Image size 2352x1568. 45° FOV. CFP:
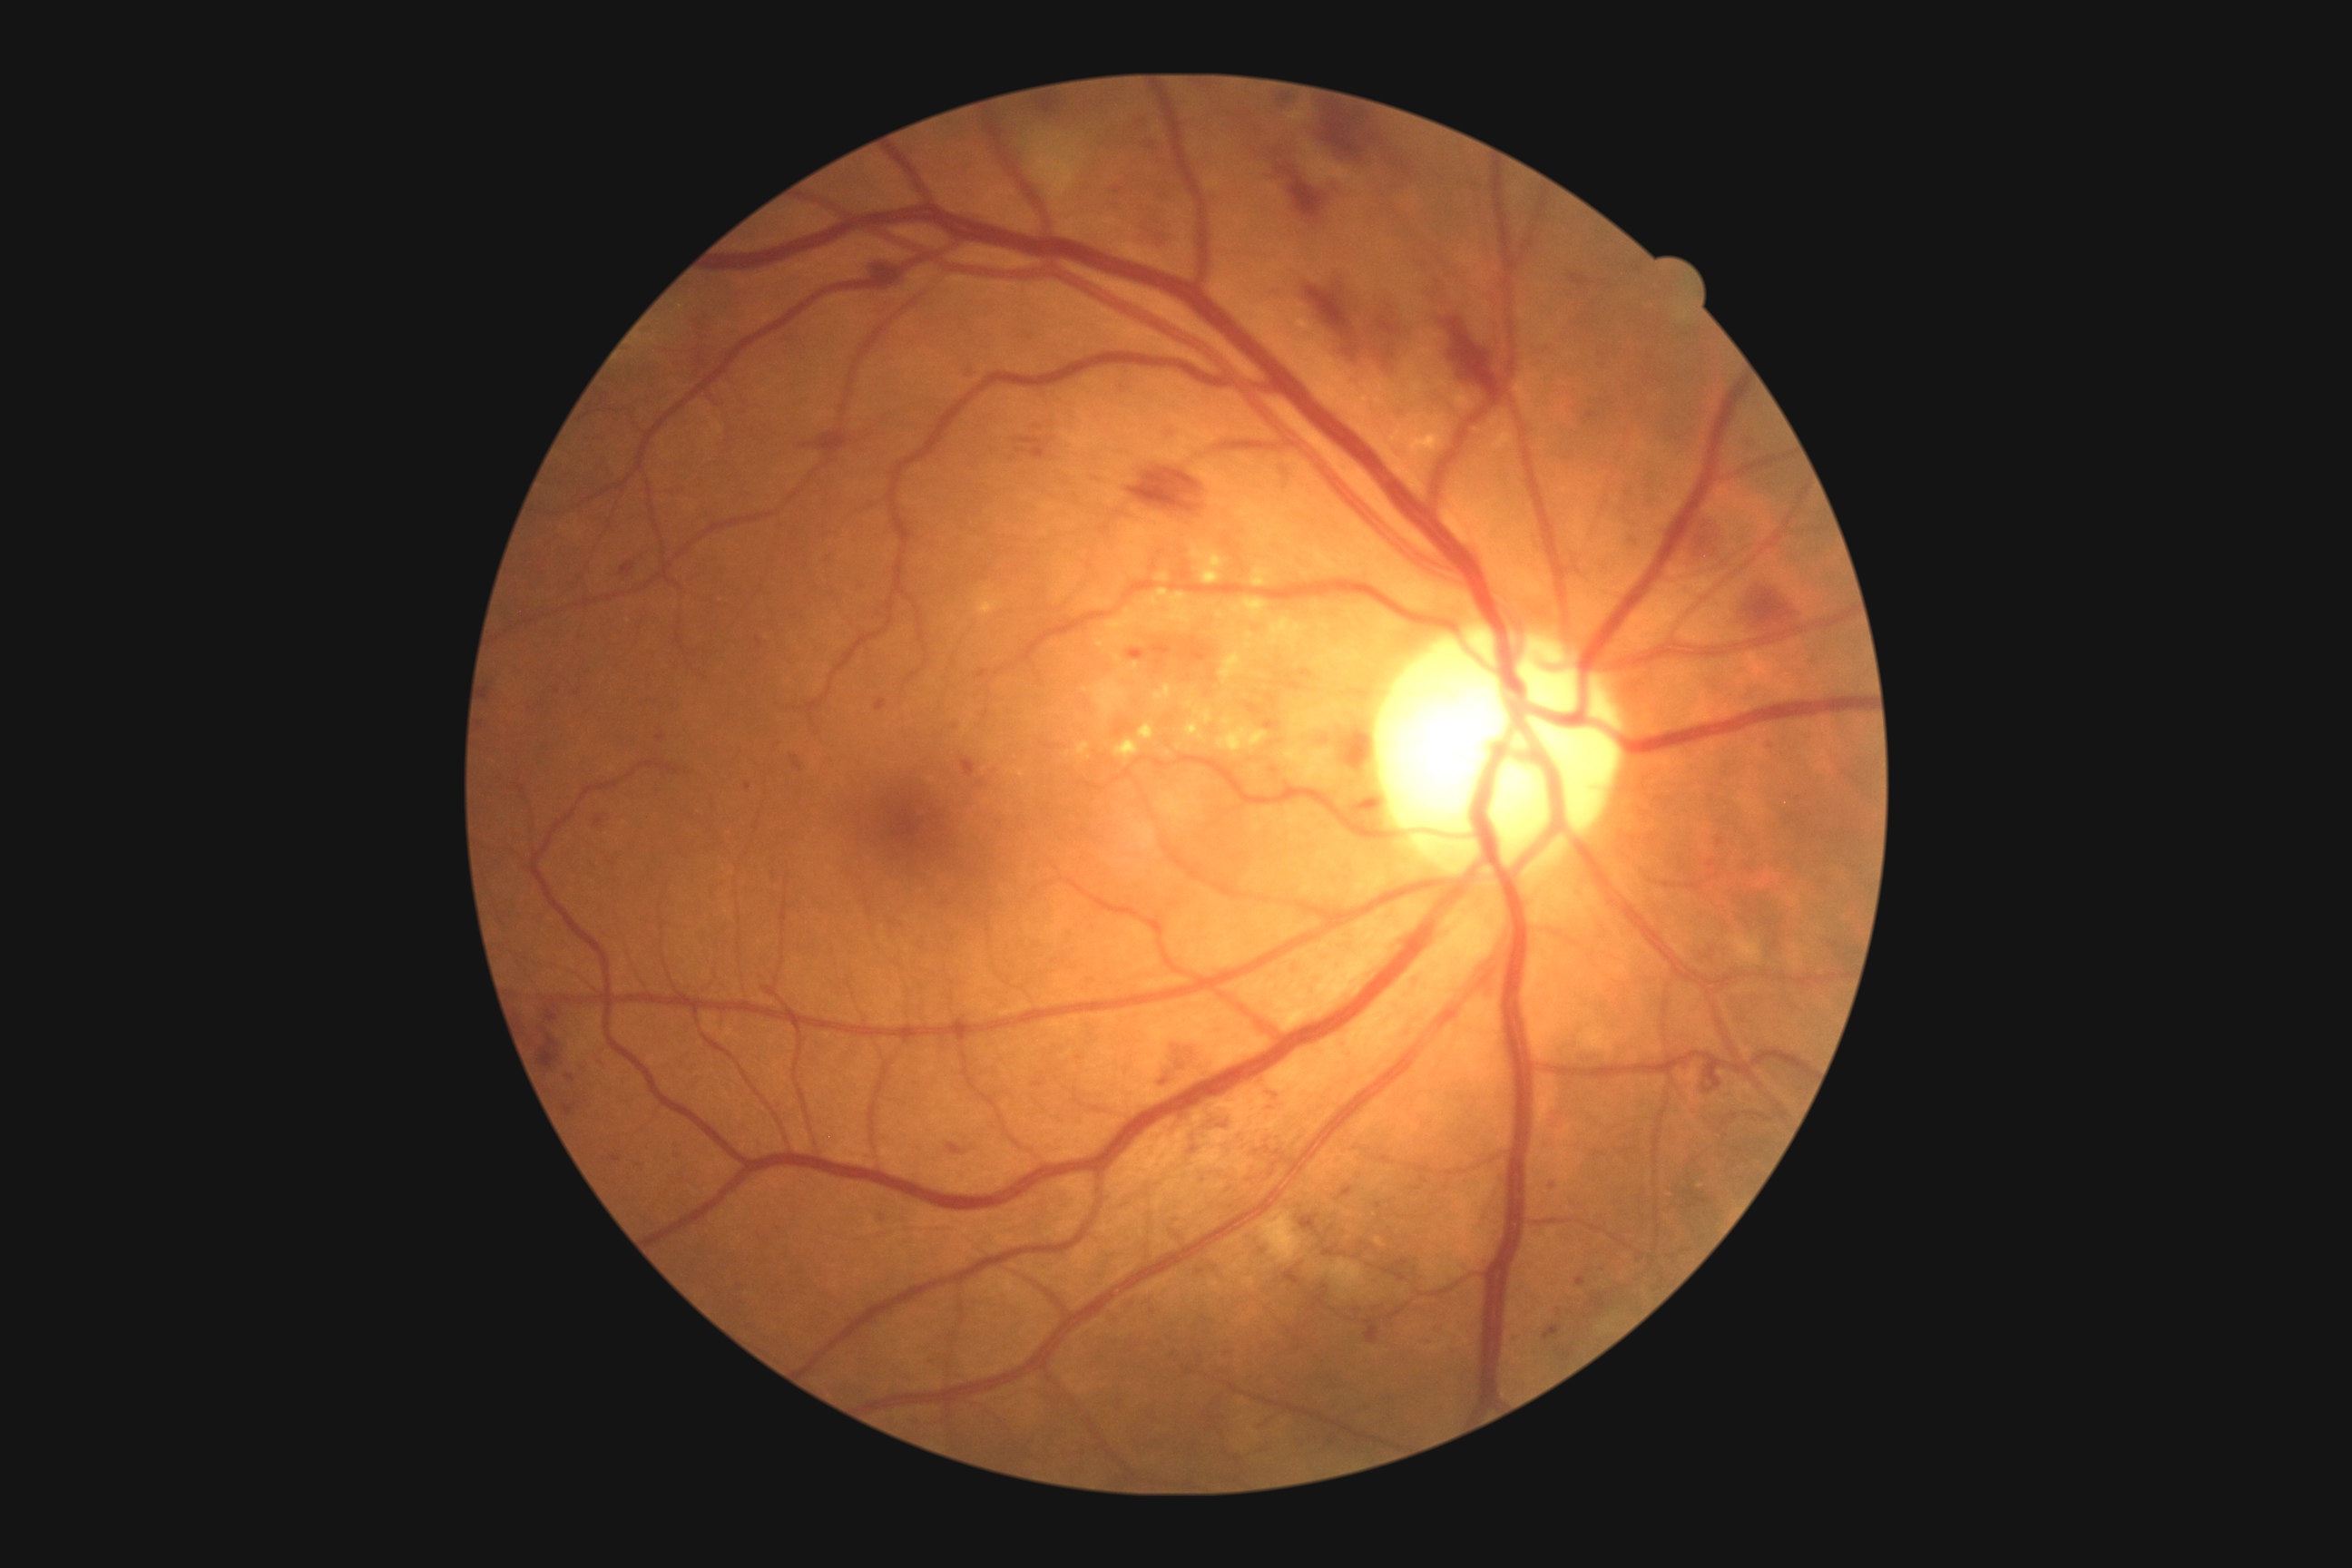 diabetic retinopathy (DR) = moderate NPDR (grade 2).